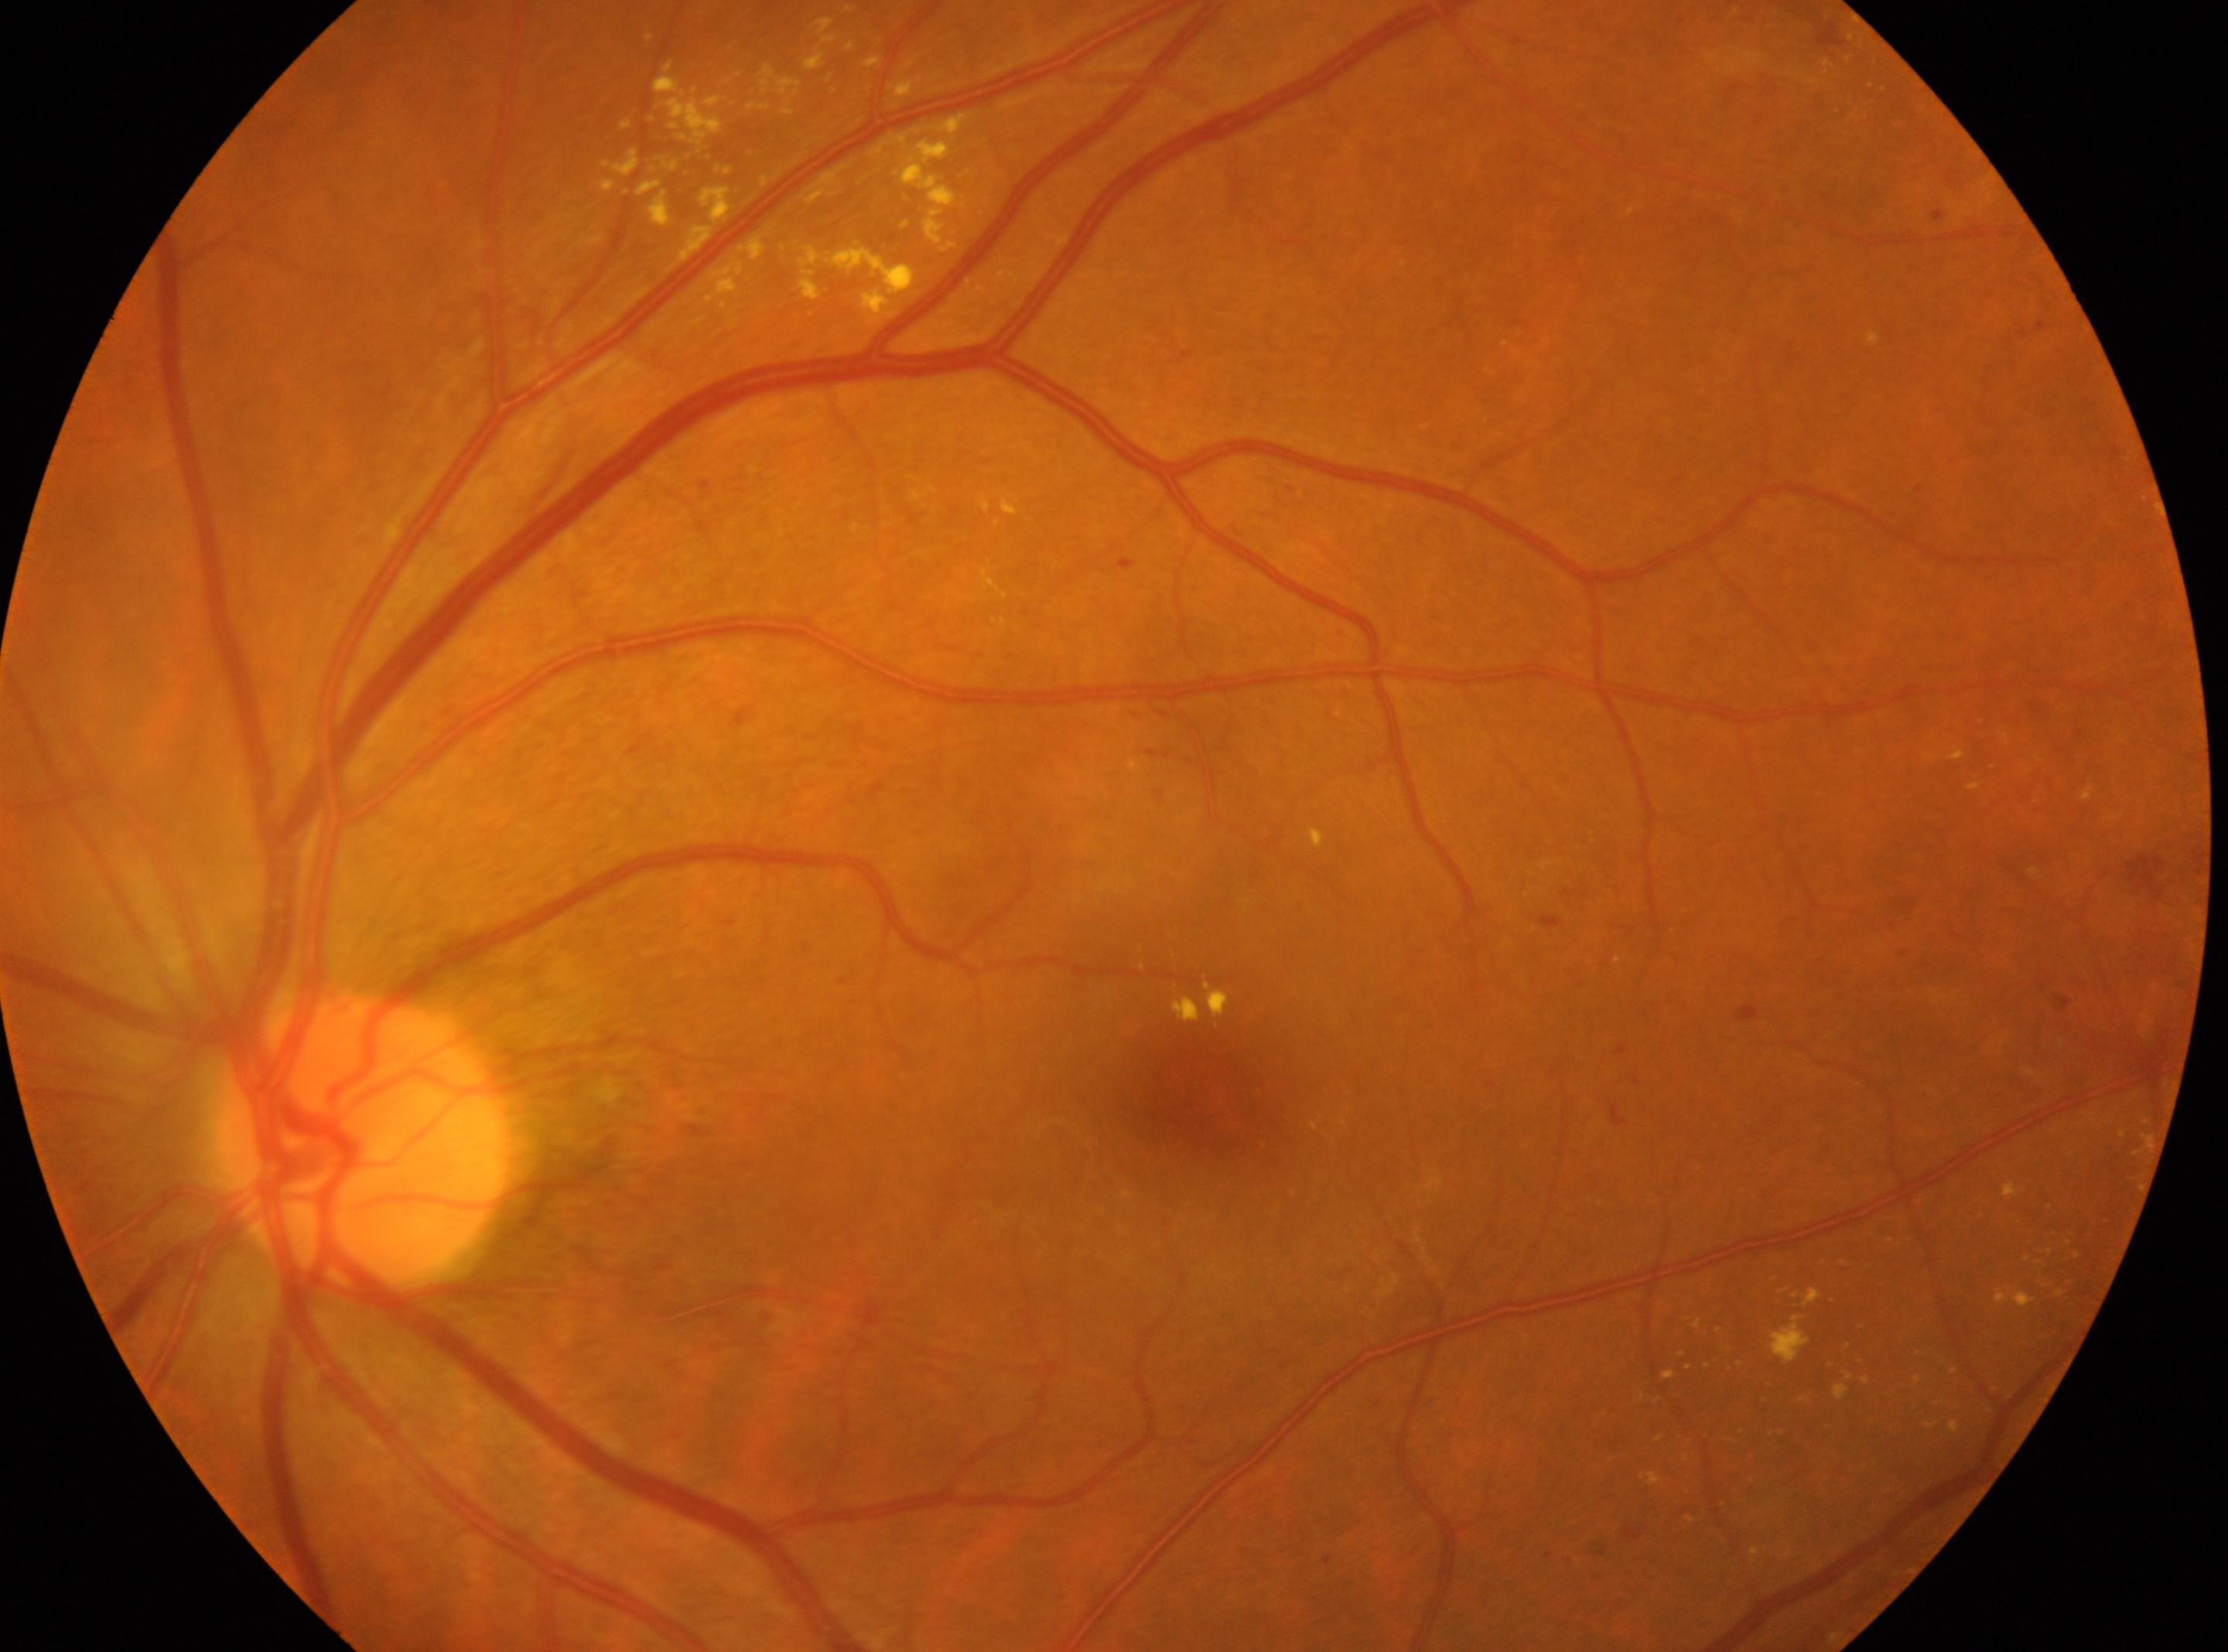
DR stage is grade 2 (moderate NPDR) — more than just microaneurysms but less than severe NPDR.
Foveal center: [1207, 1097].
Imaged eye: OS.
ONH located at [364, 1136].